Davis DR grading · FOV: 45 degrees: 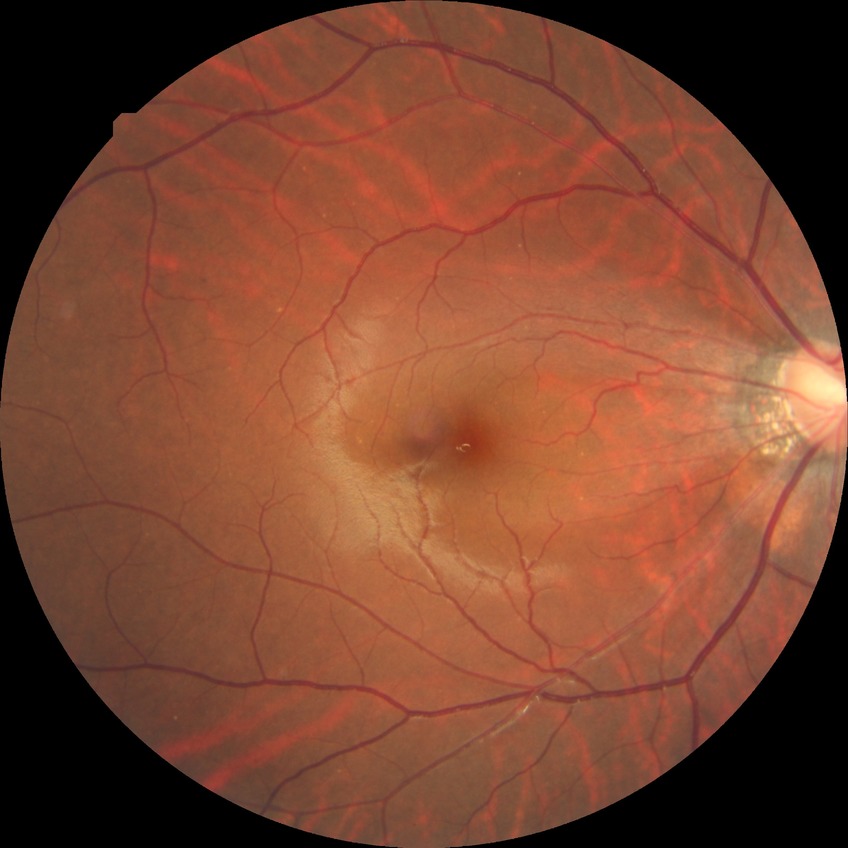

Diabetic retinopathy severity: simple diabetic retinopathy.